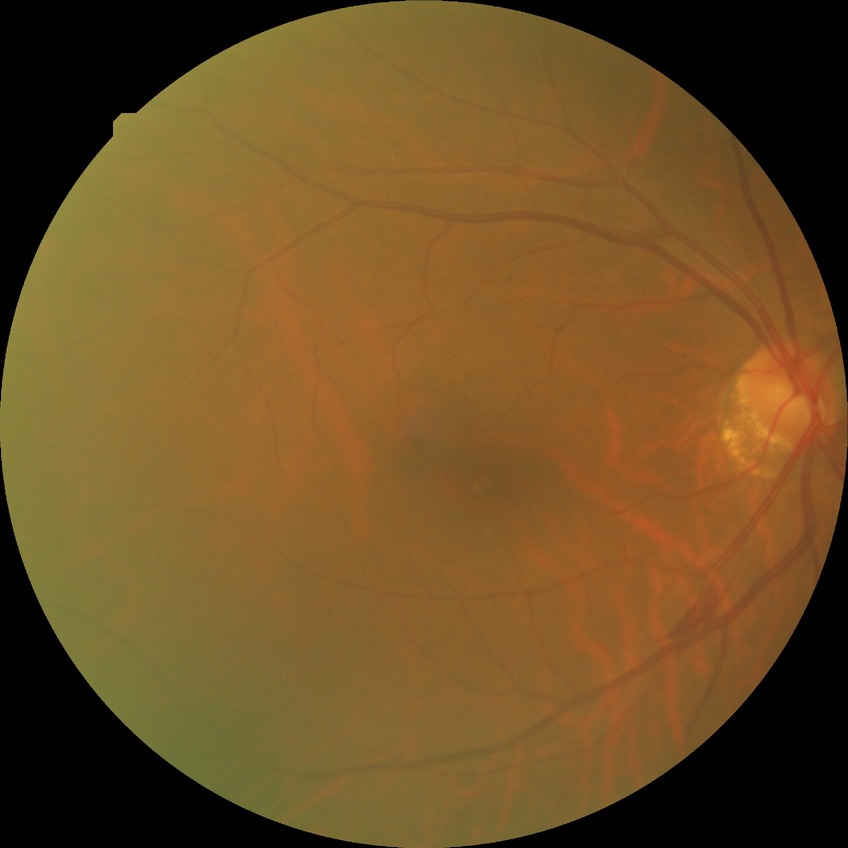
Diabetic retinopathy (DR) is simple diabetic retinopathy (SDR).